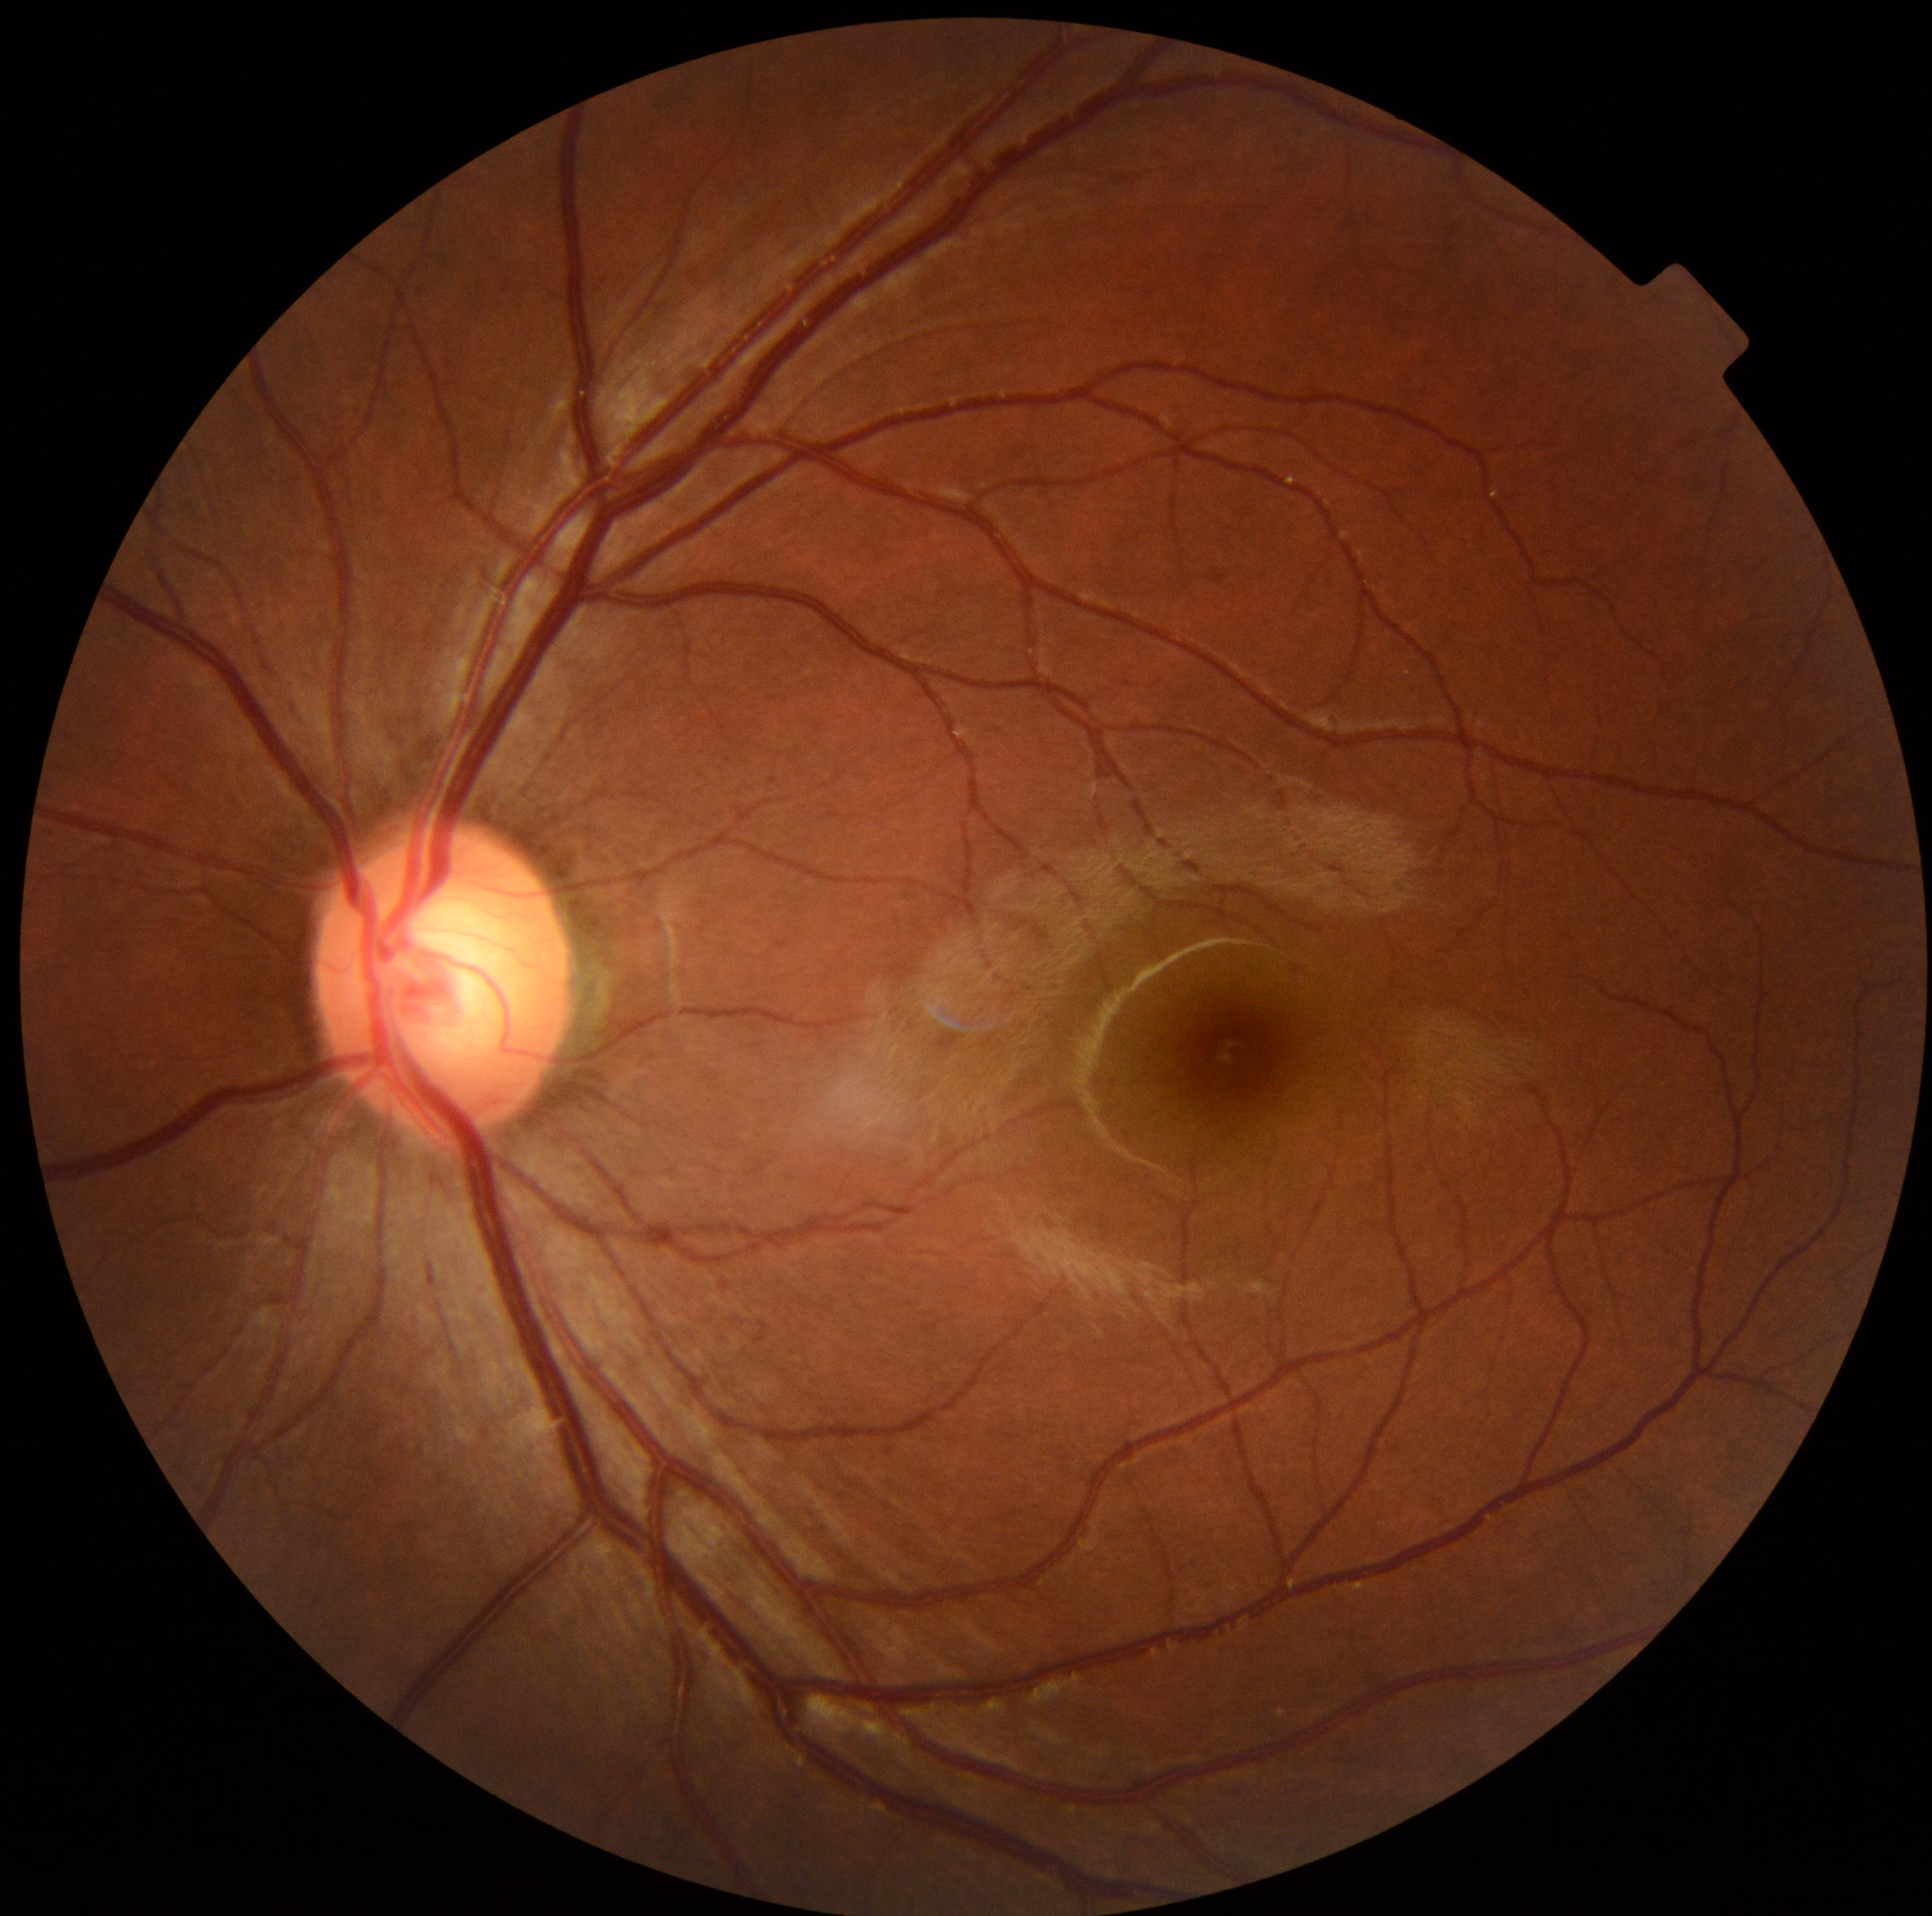 {
  "dr_grade": "grade 0",
  "dr_impression": "no DR findings"
}